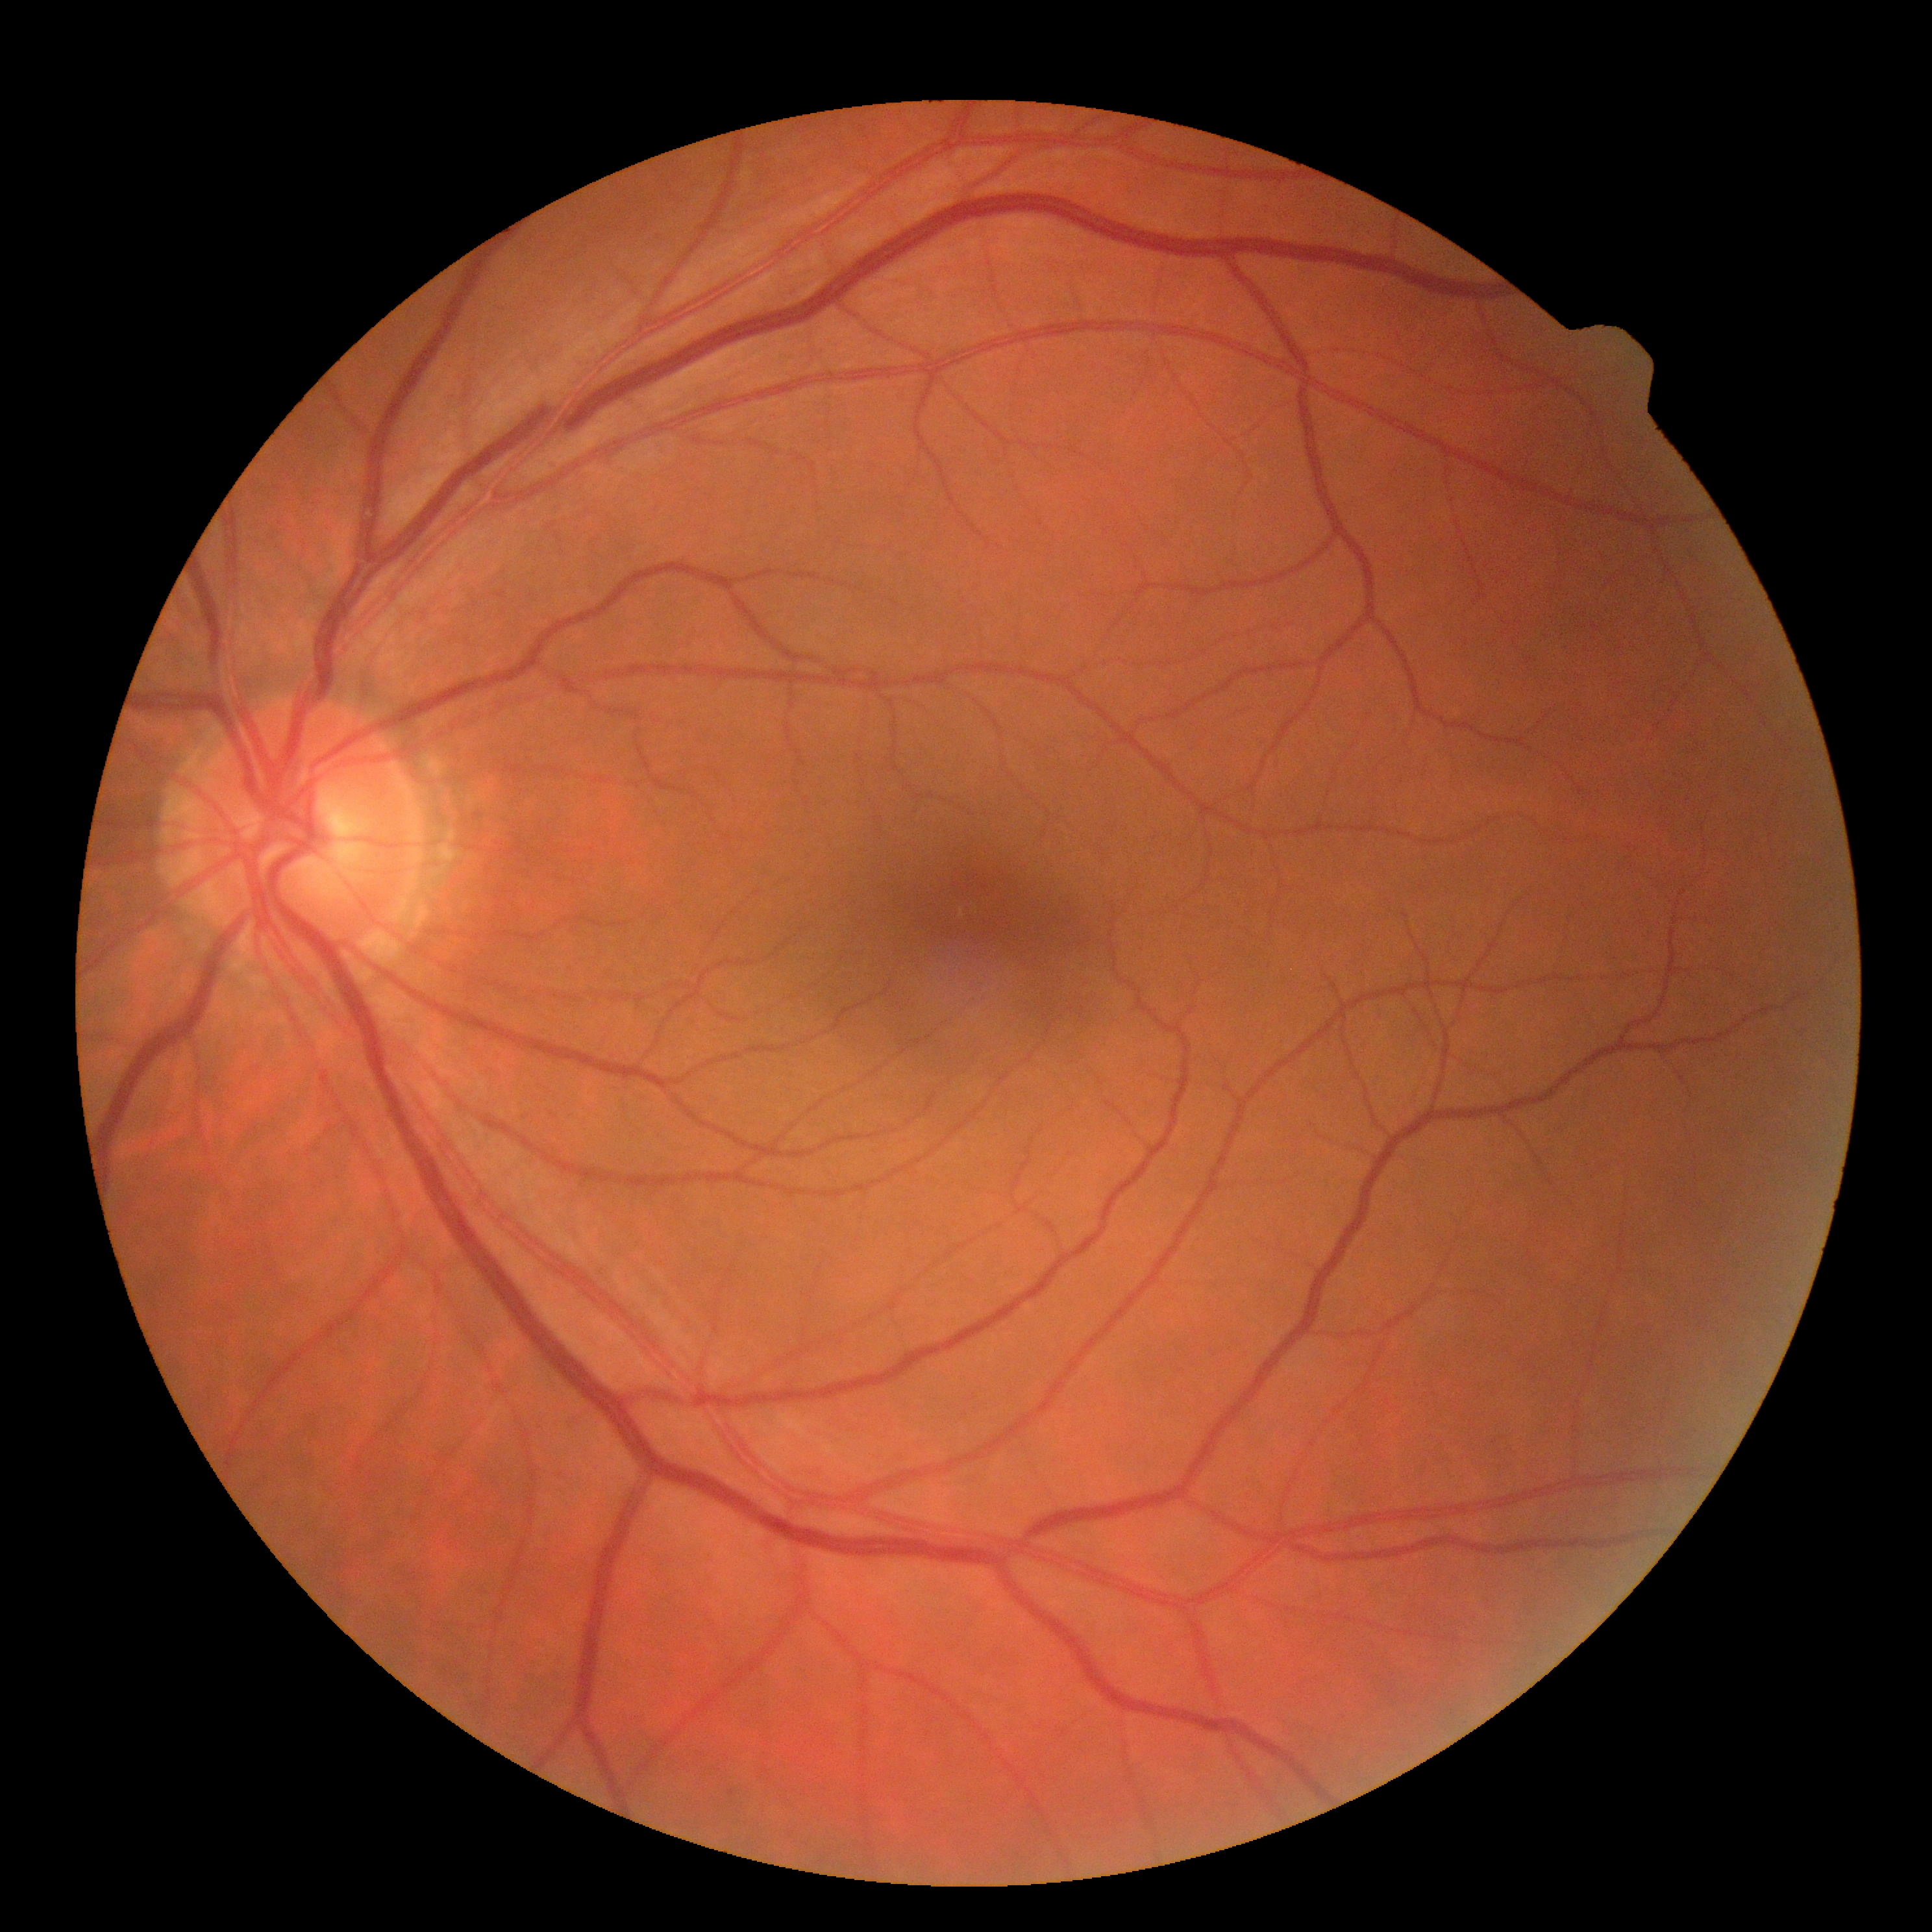 DR: 0/4.